FOV: 45 degrees. Fundus photo. Nonmydriatic — 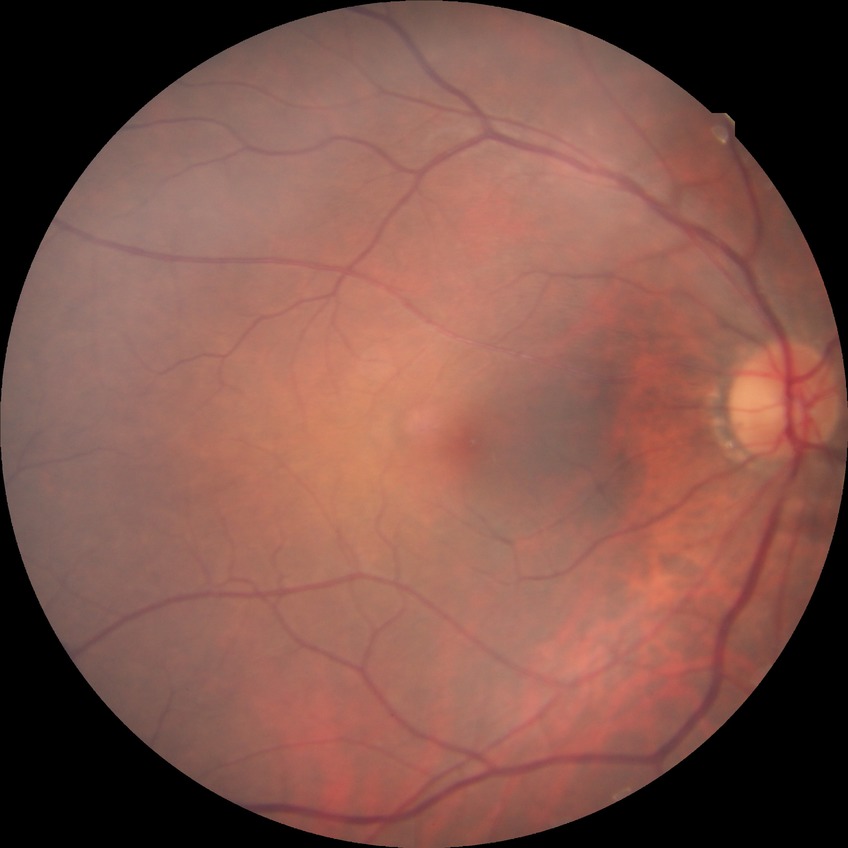   davis_grade: no diabetic retinopathy